NIDEK AFC-230. Without pupil dilation
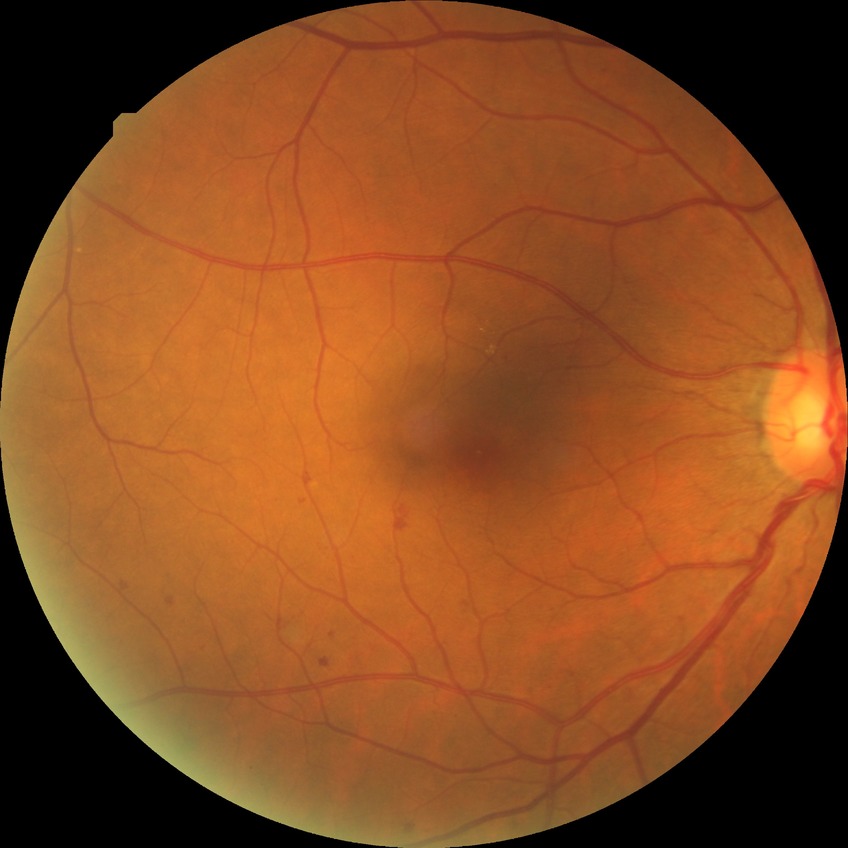

DR class: non-proliferative diabetic retinopathy.
Diabetic retinopathy (DR): SDR (simple diabetic retinopathy).